Acquired on the Phoenix ICON · infant wide-field retinal image.
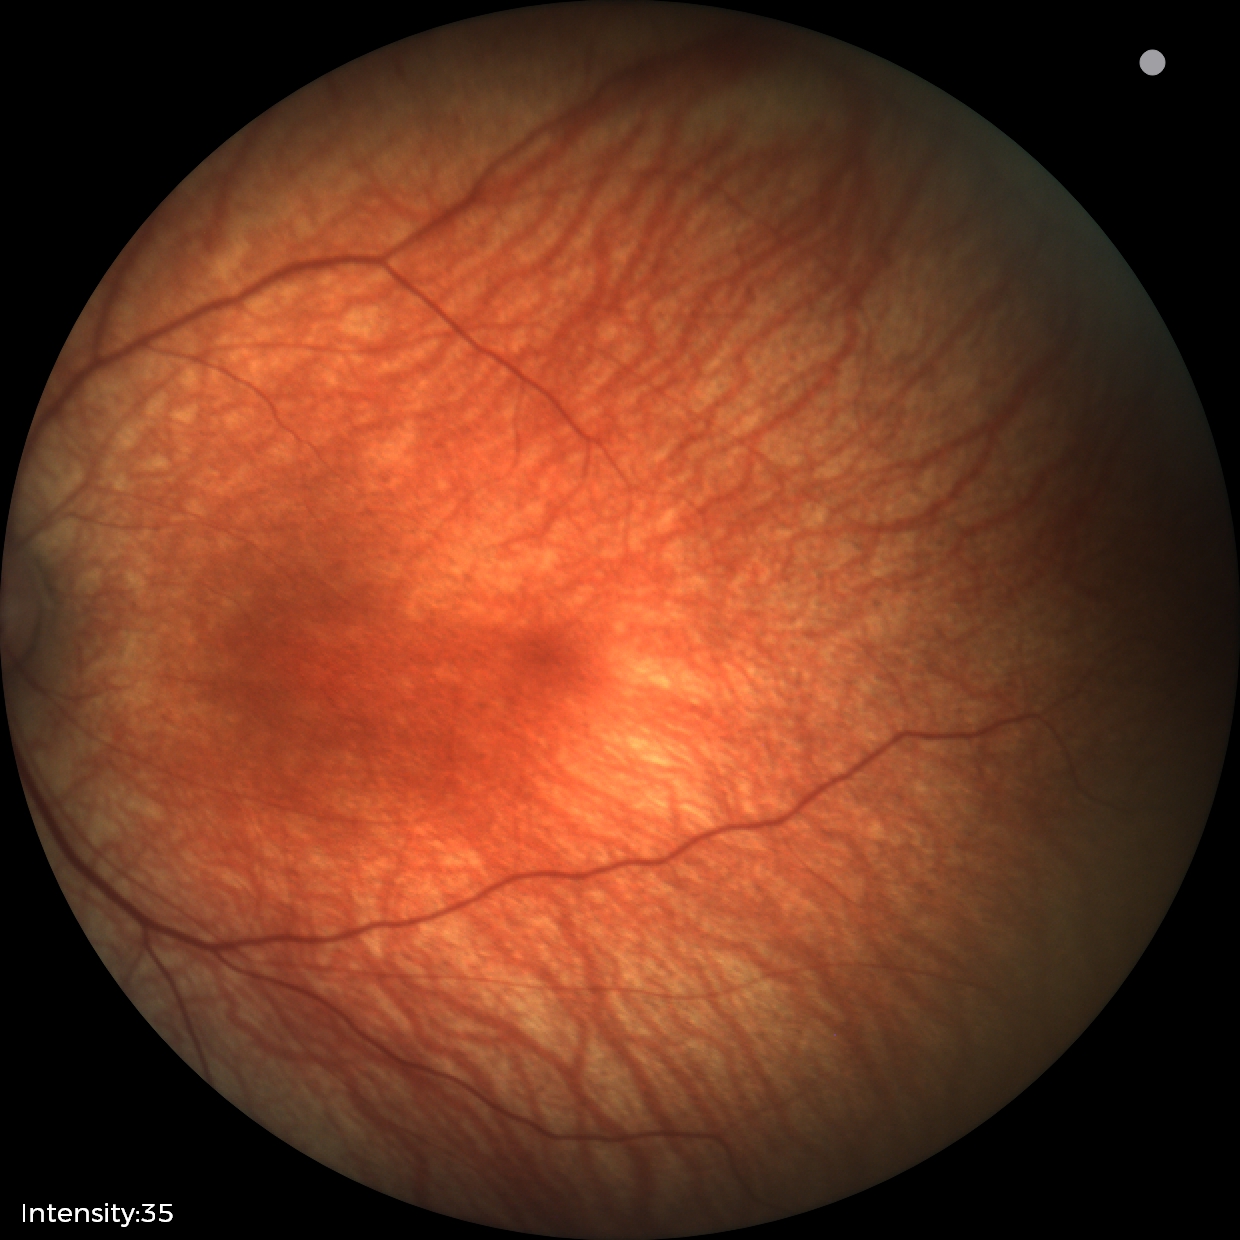 Examination with physiological retinal findings.